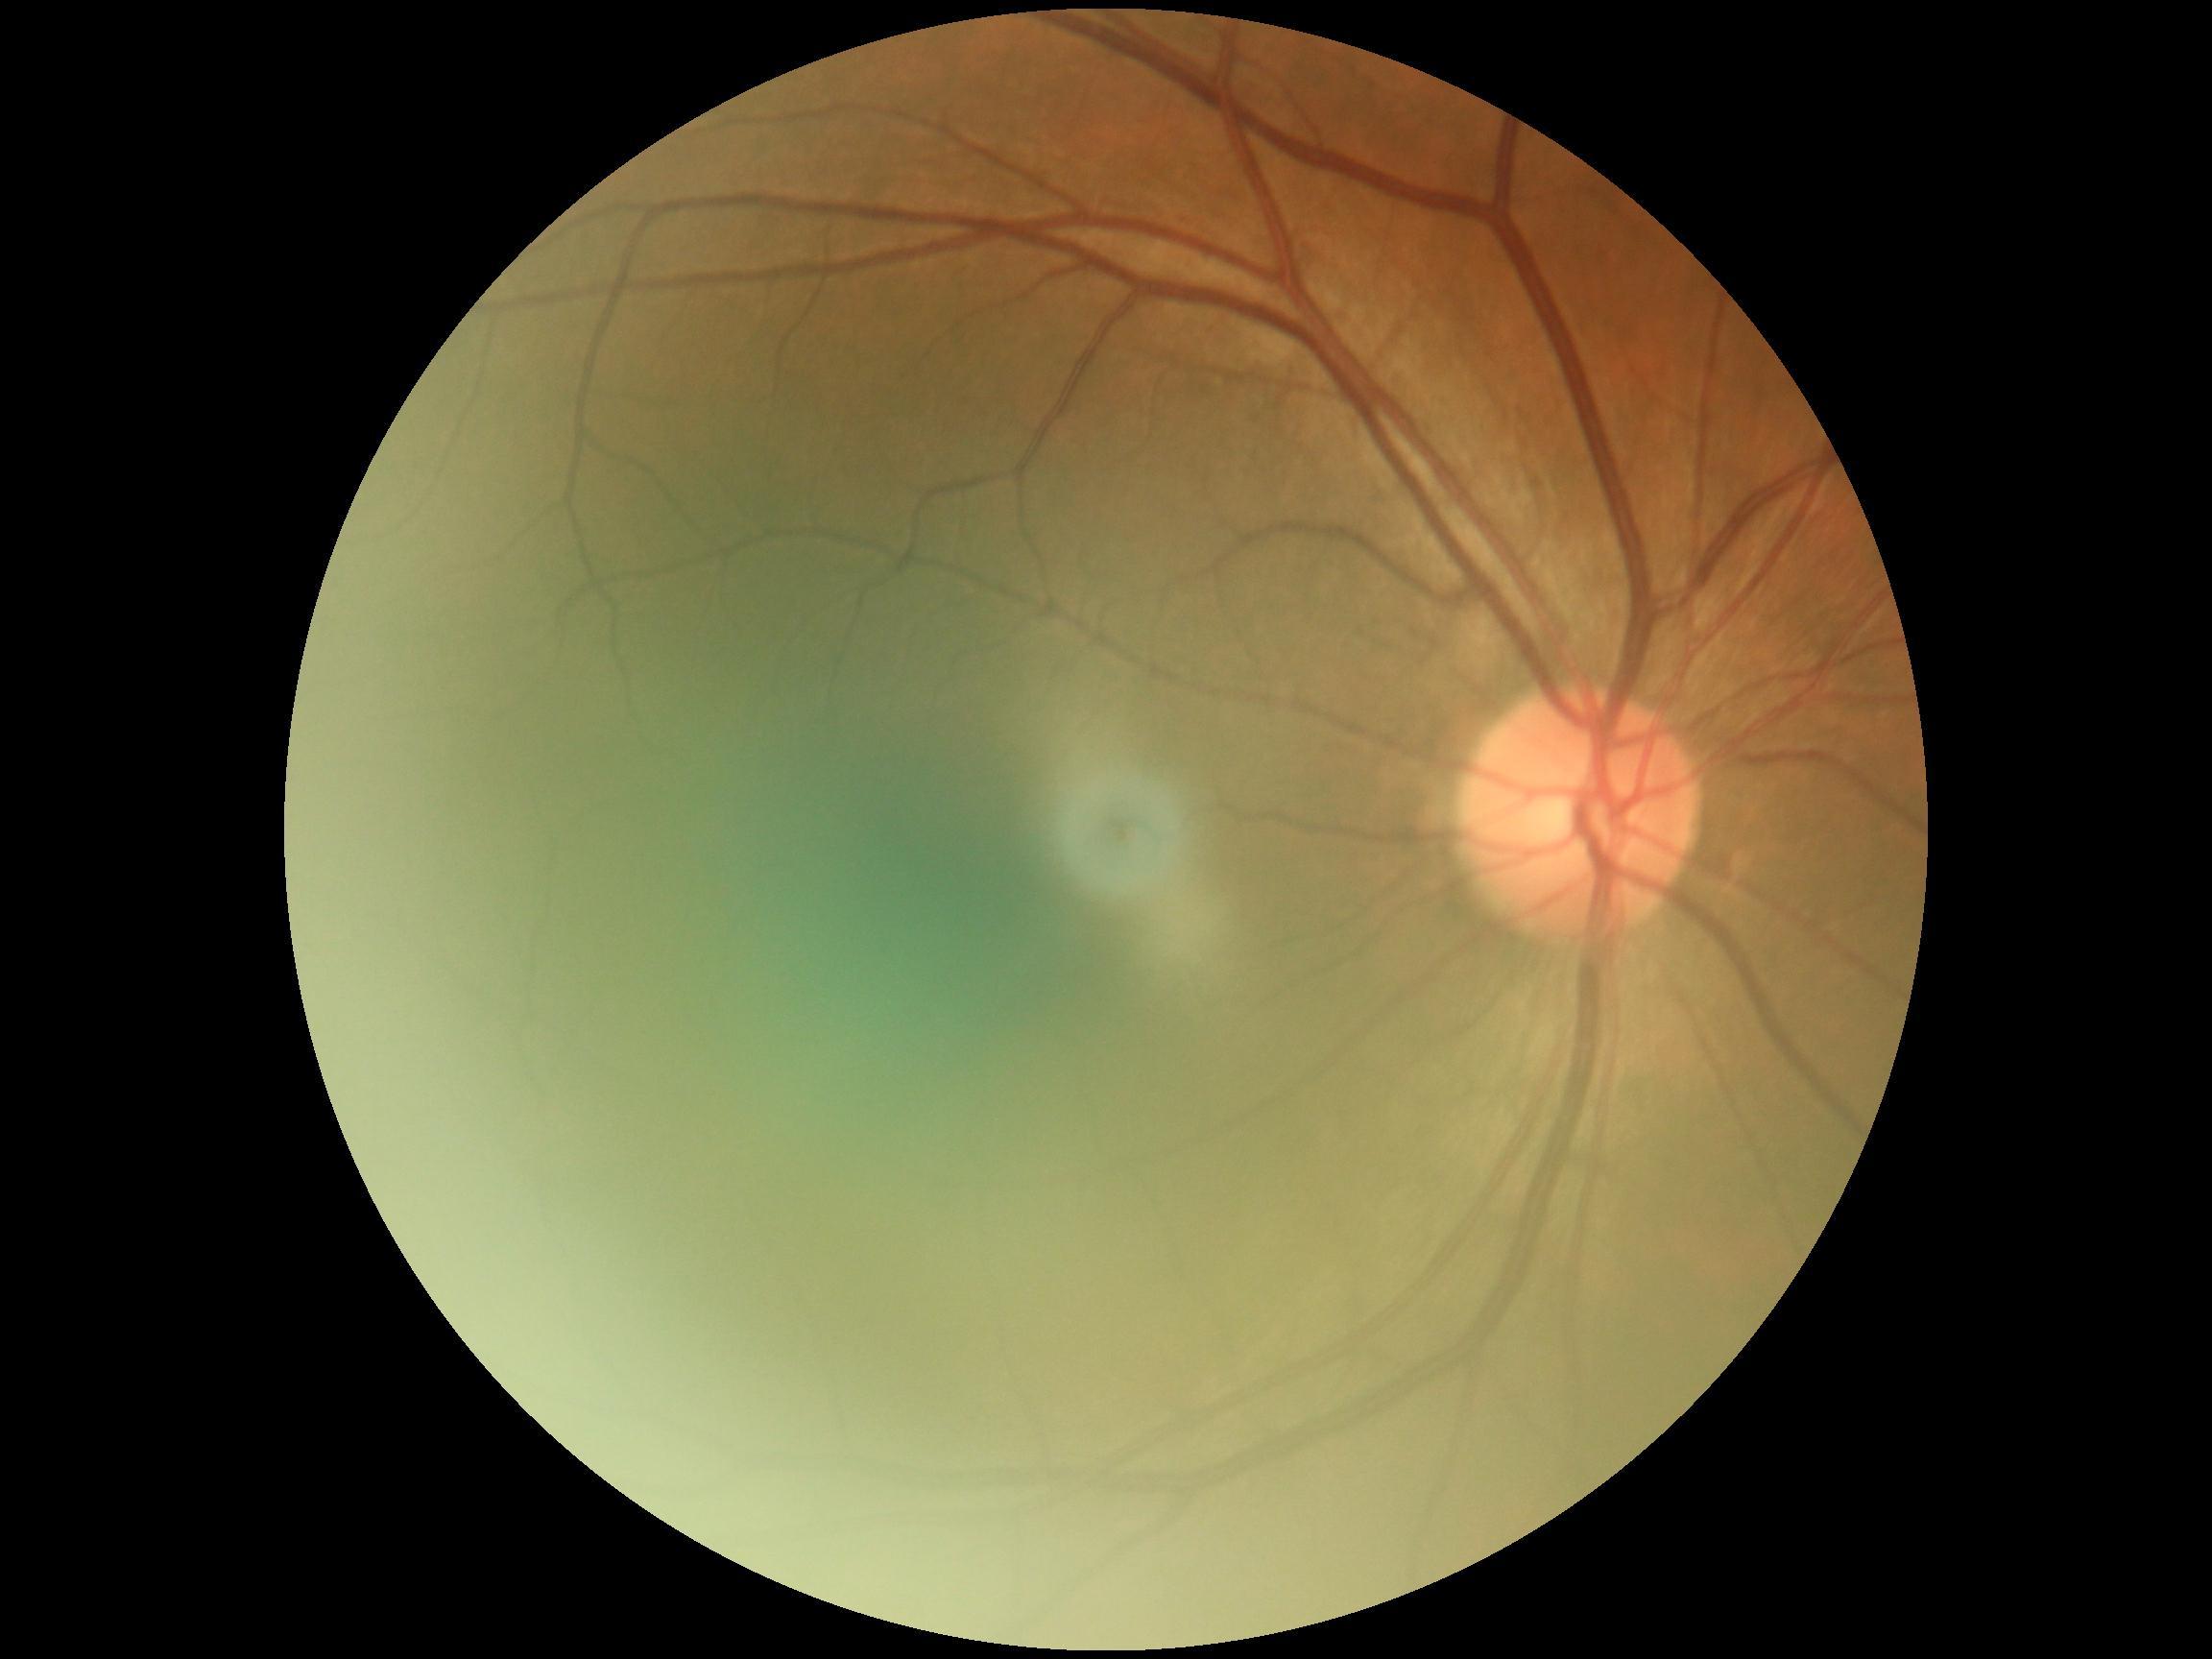
DR grade: 0.